Retinal fundus photograph
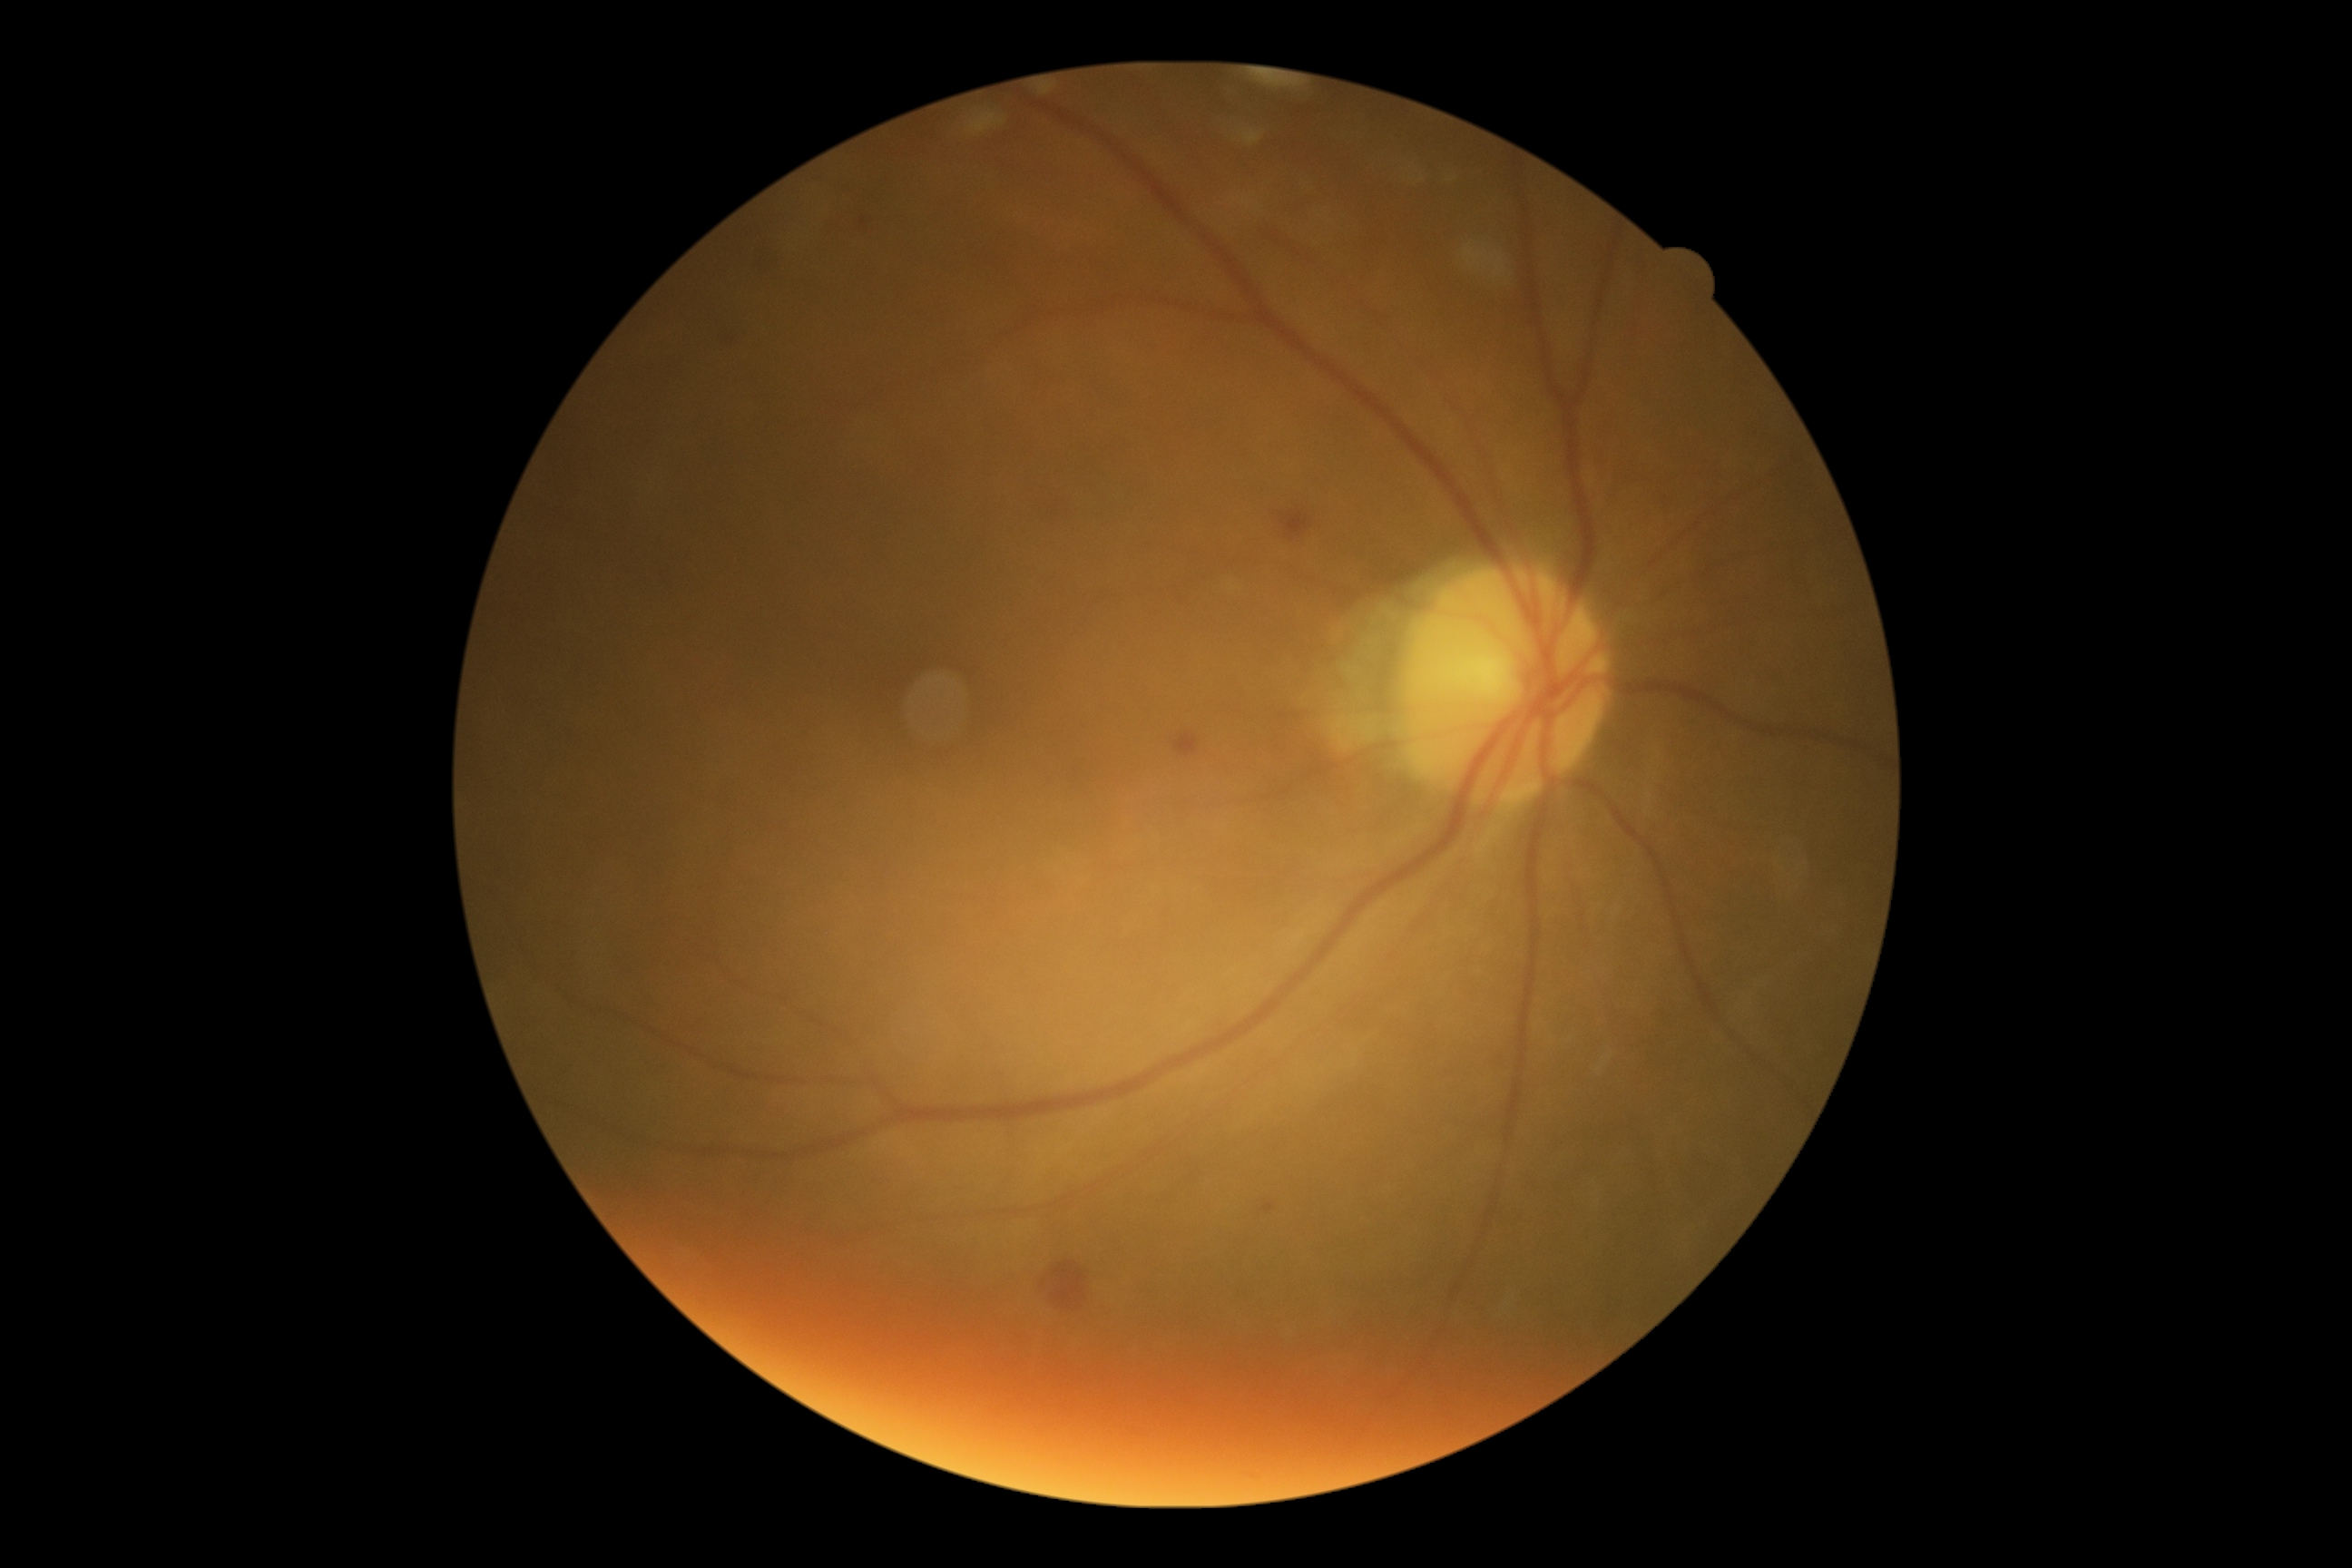

Diabetic retinopathy (DR): grade 2.